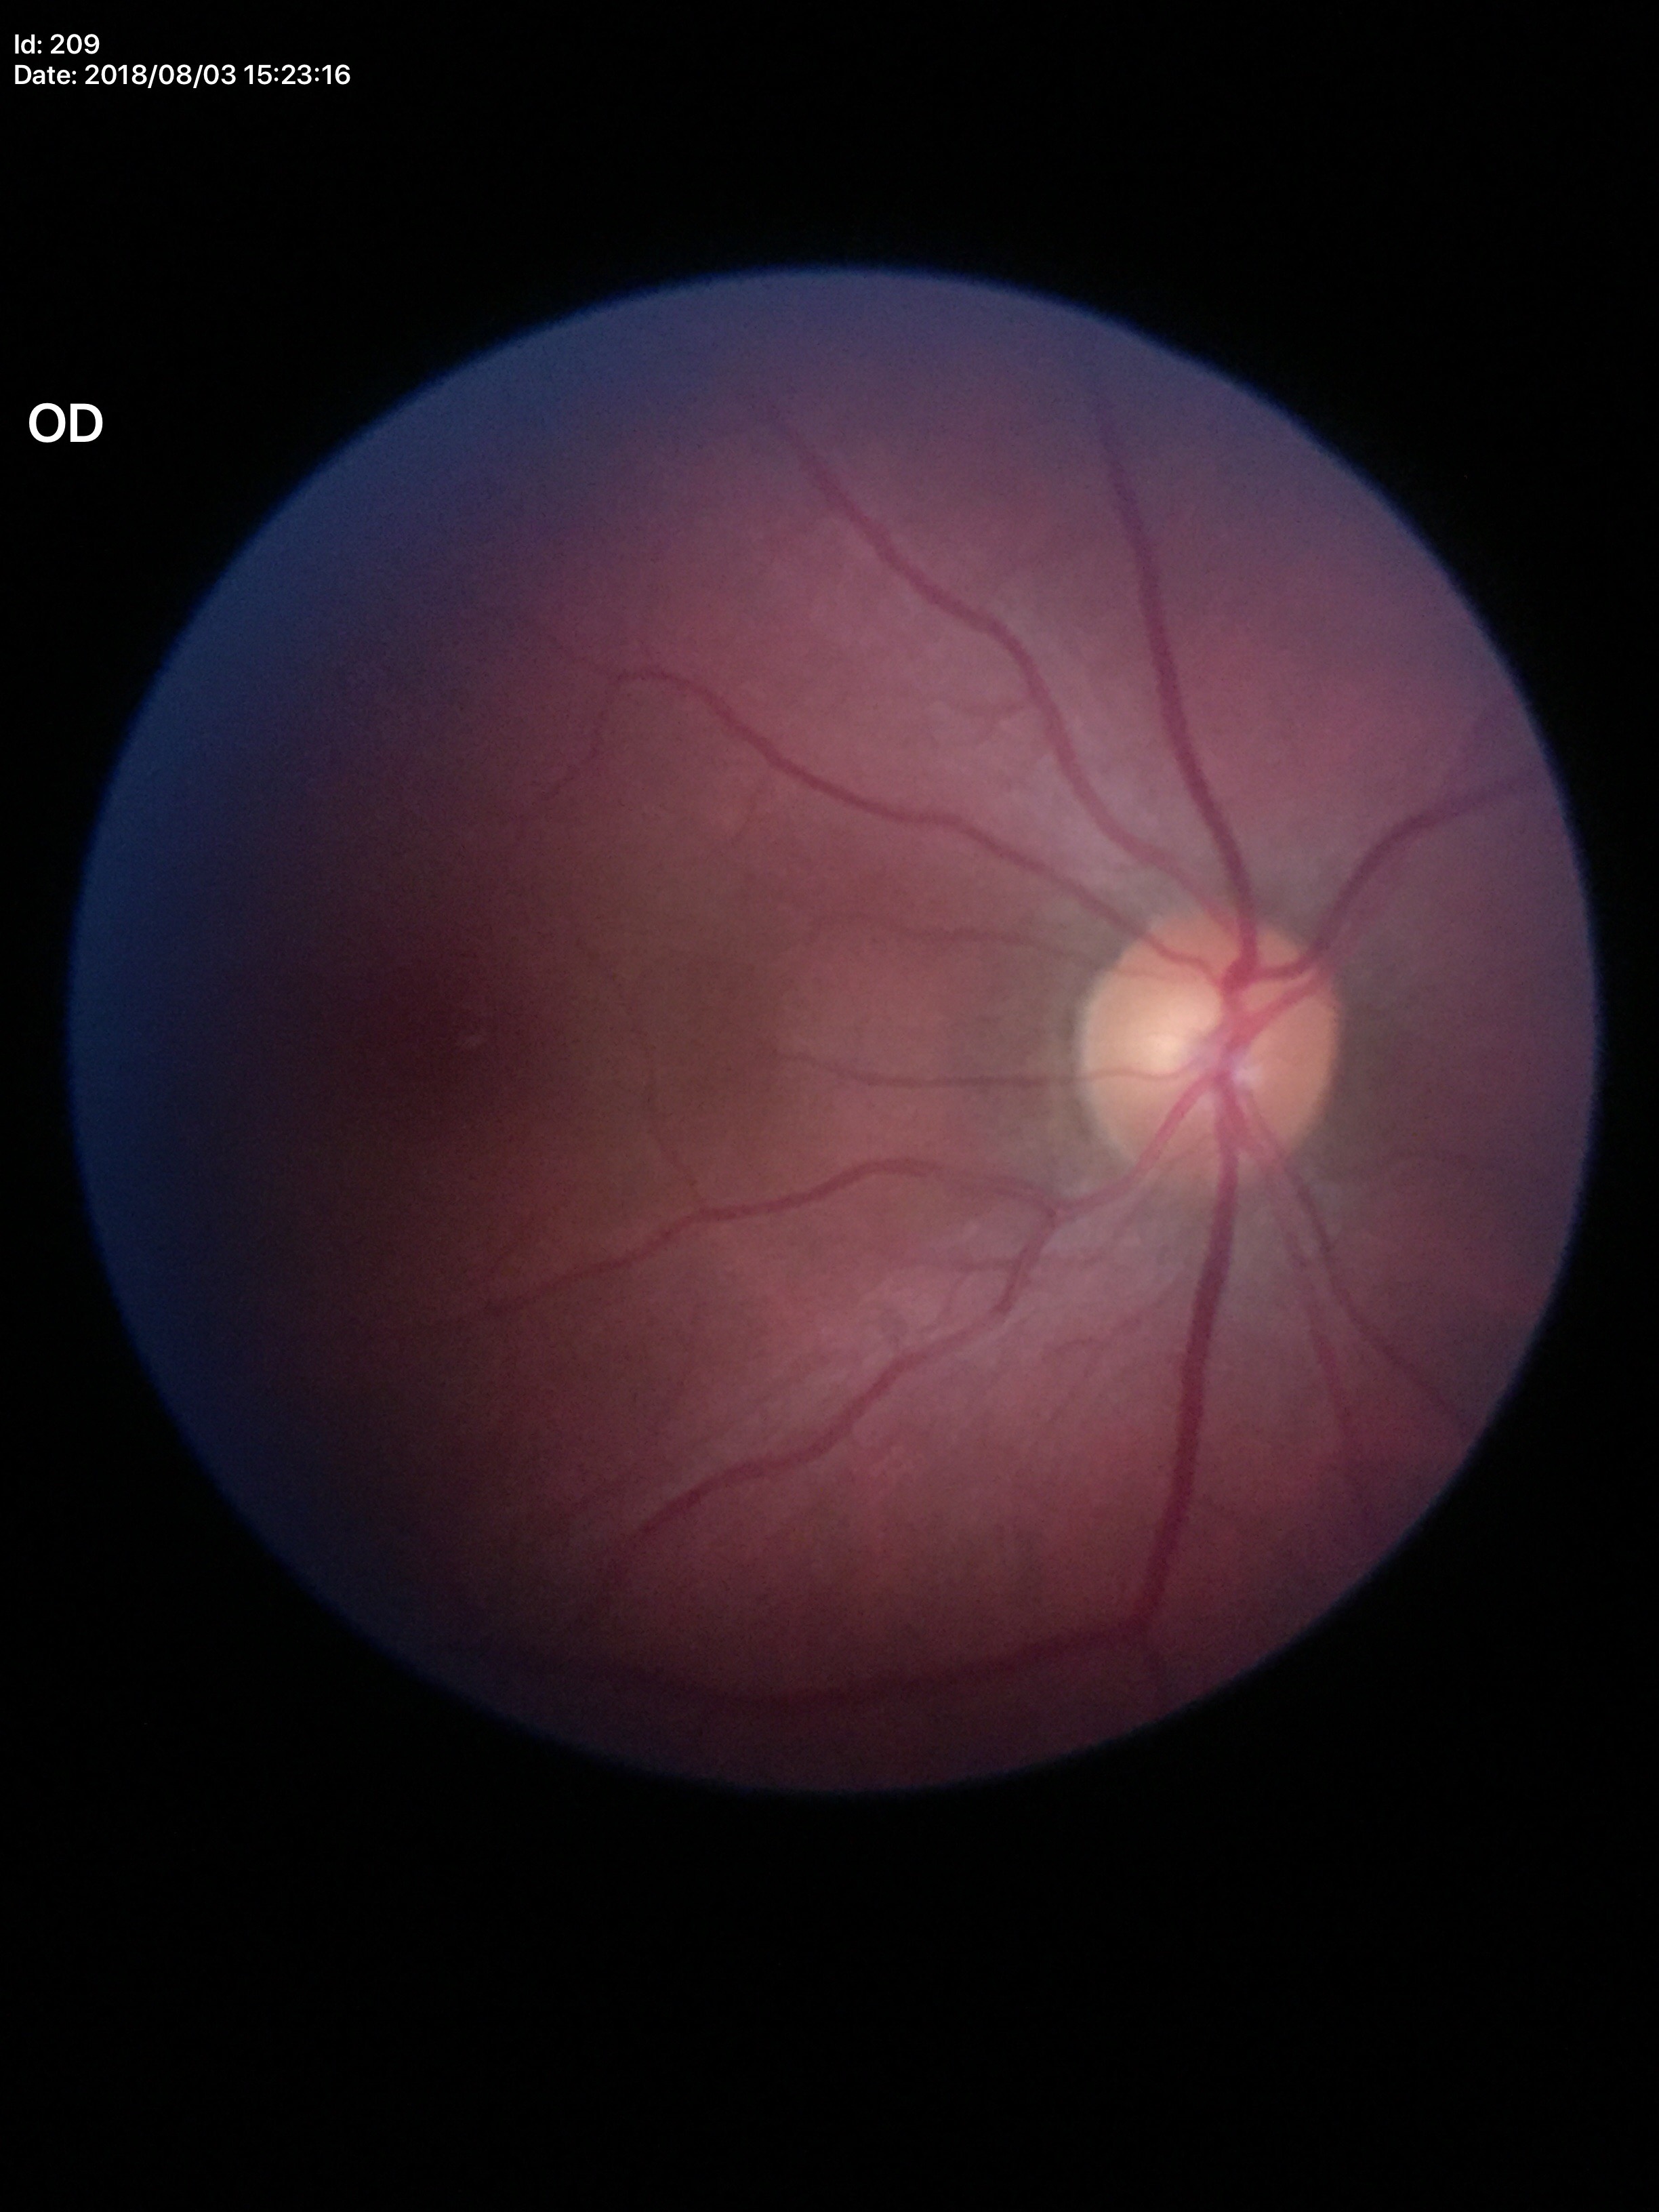 Glaucoma assessment: not suspect.
Vertical CDR of 0.52.